FOV: 45 degrees: 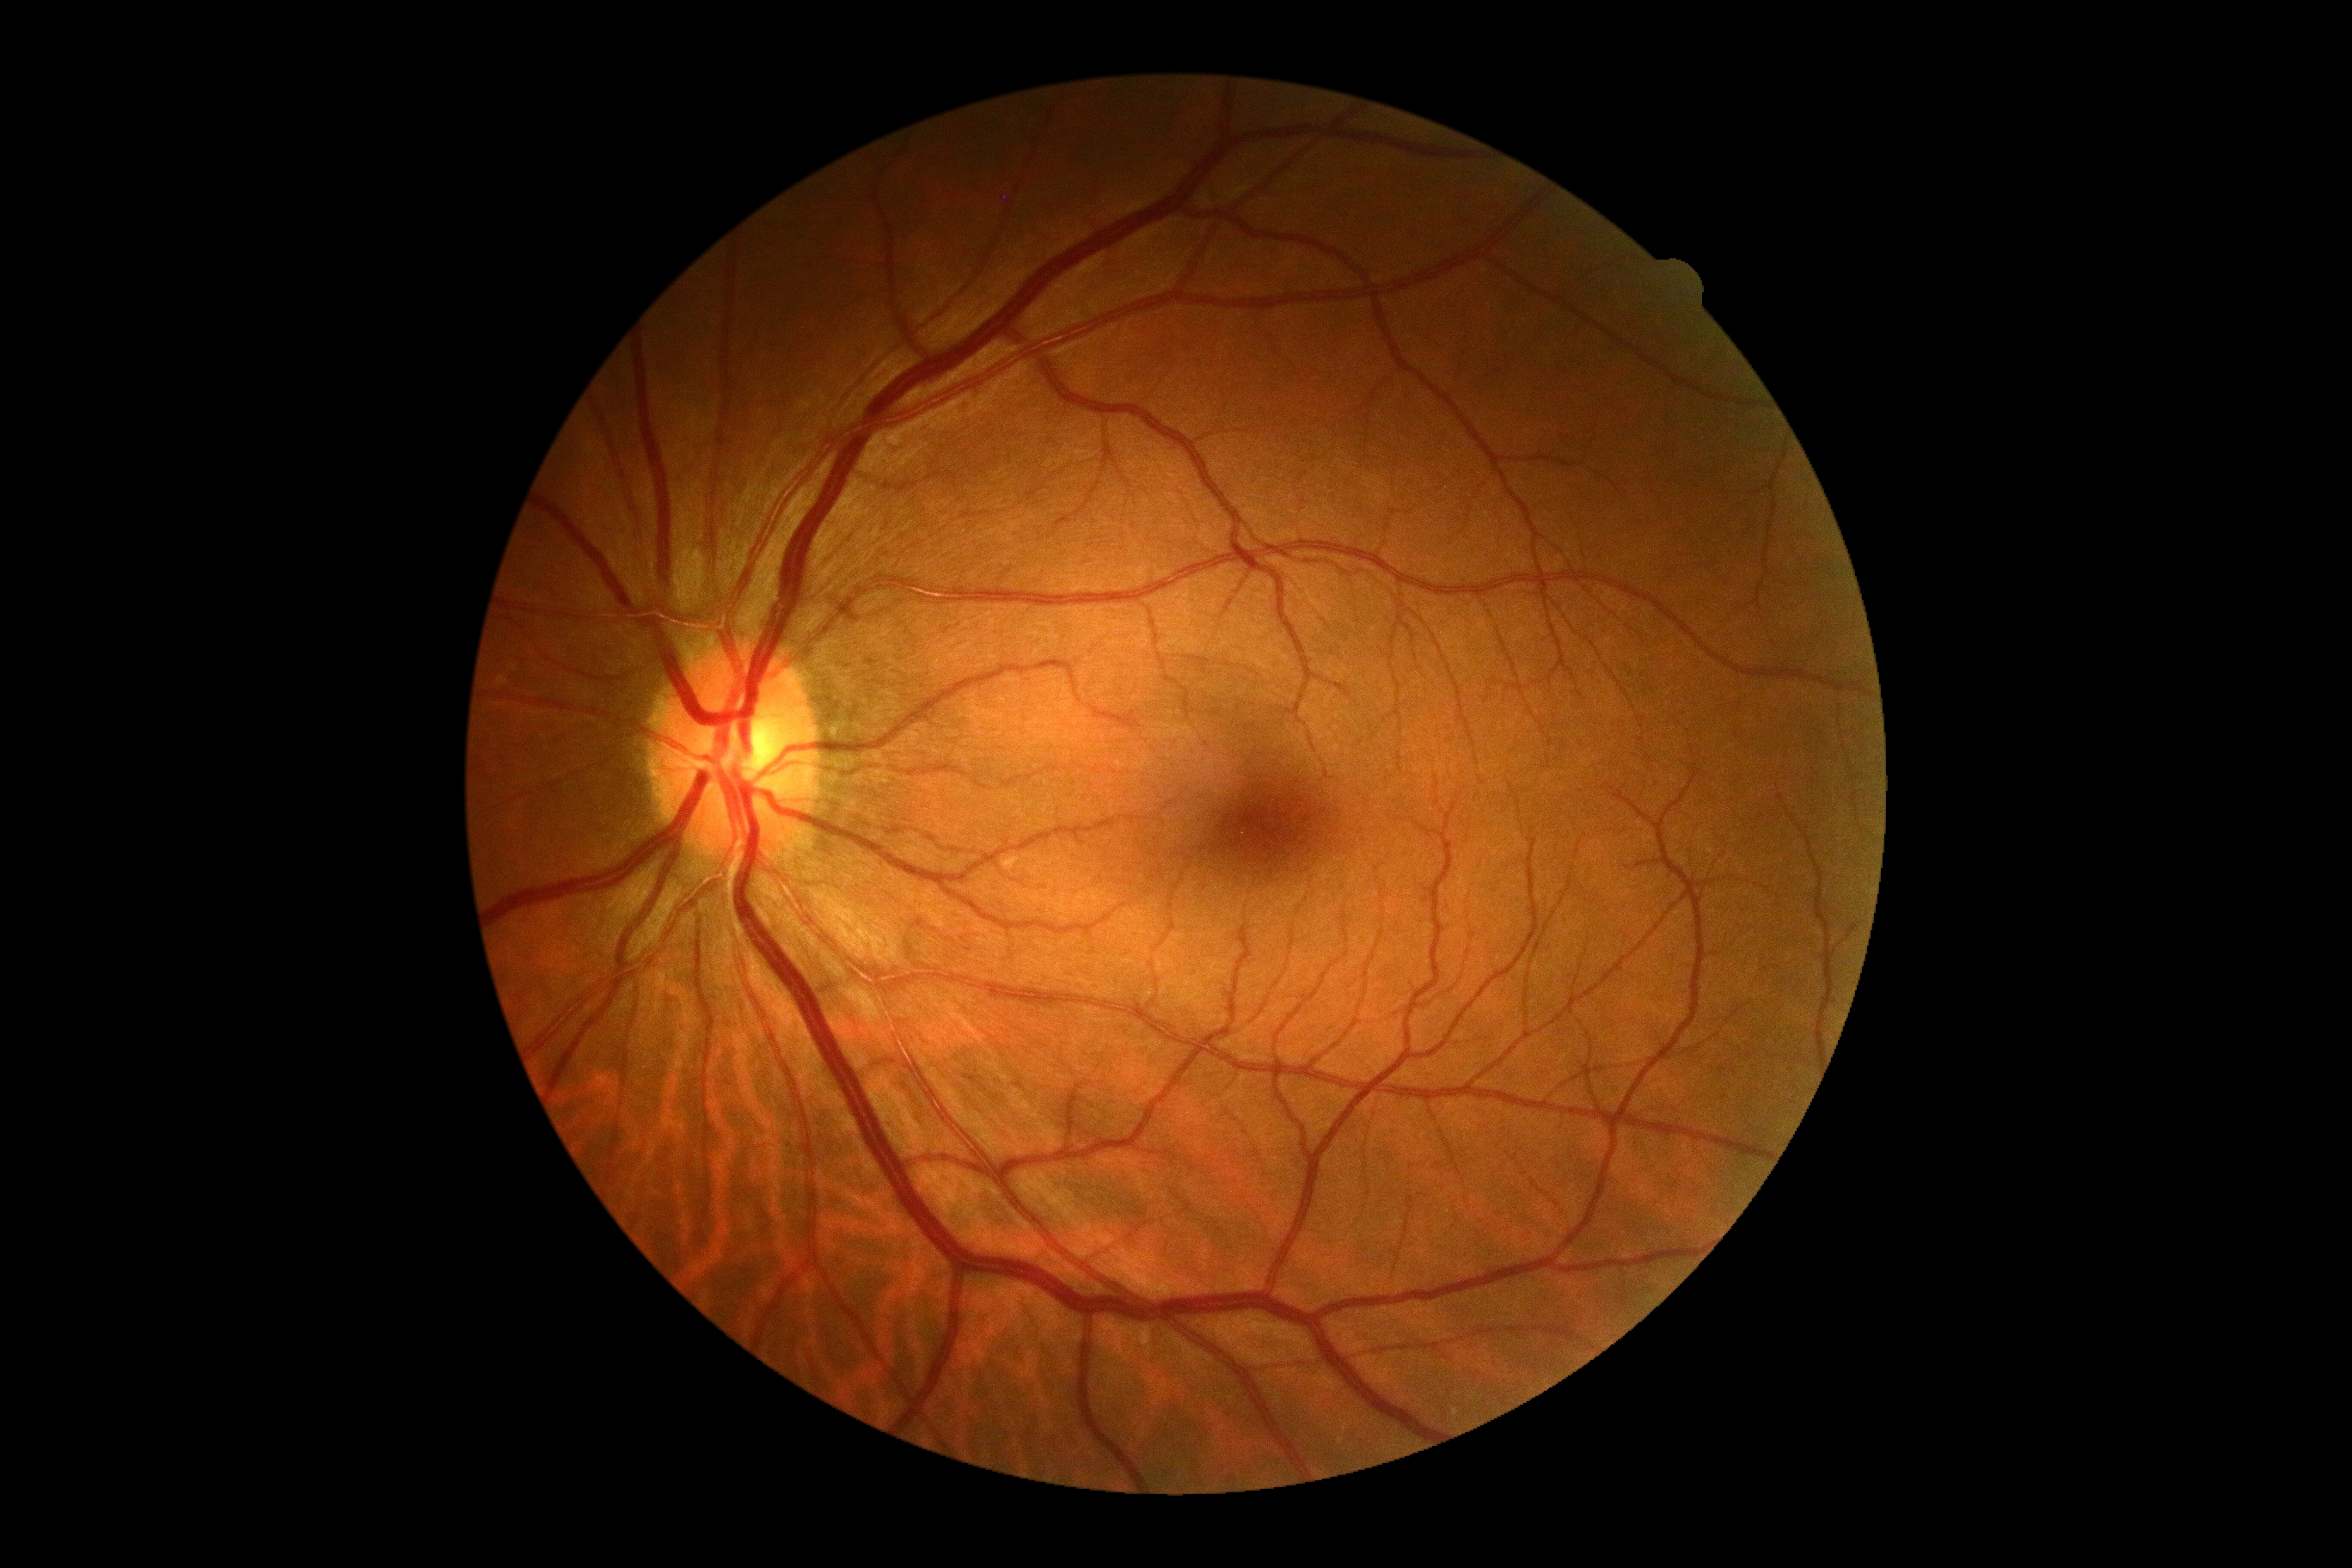

Diabetic retinopathy is no apparent retinopathy (grade 0).